Fundus photo — 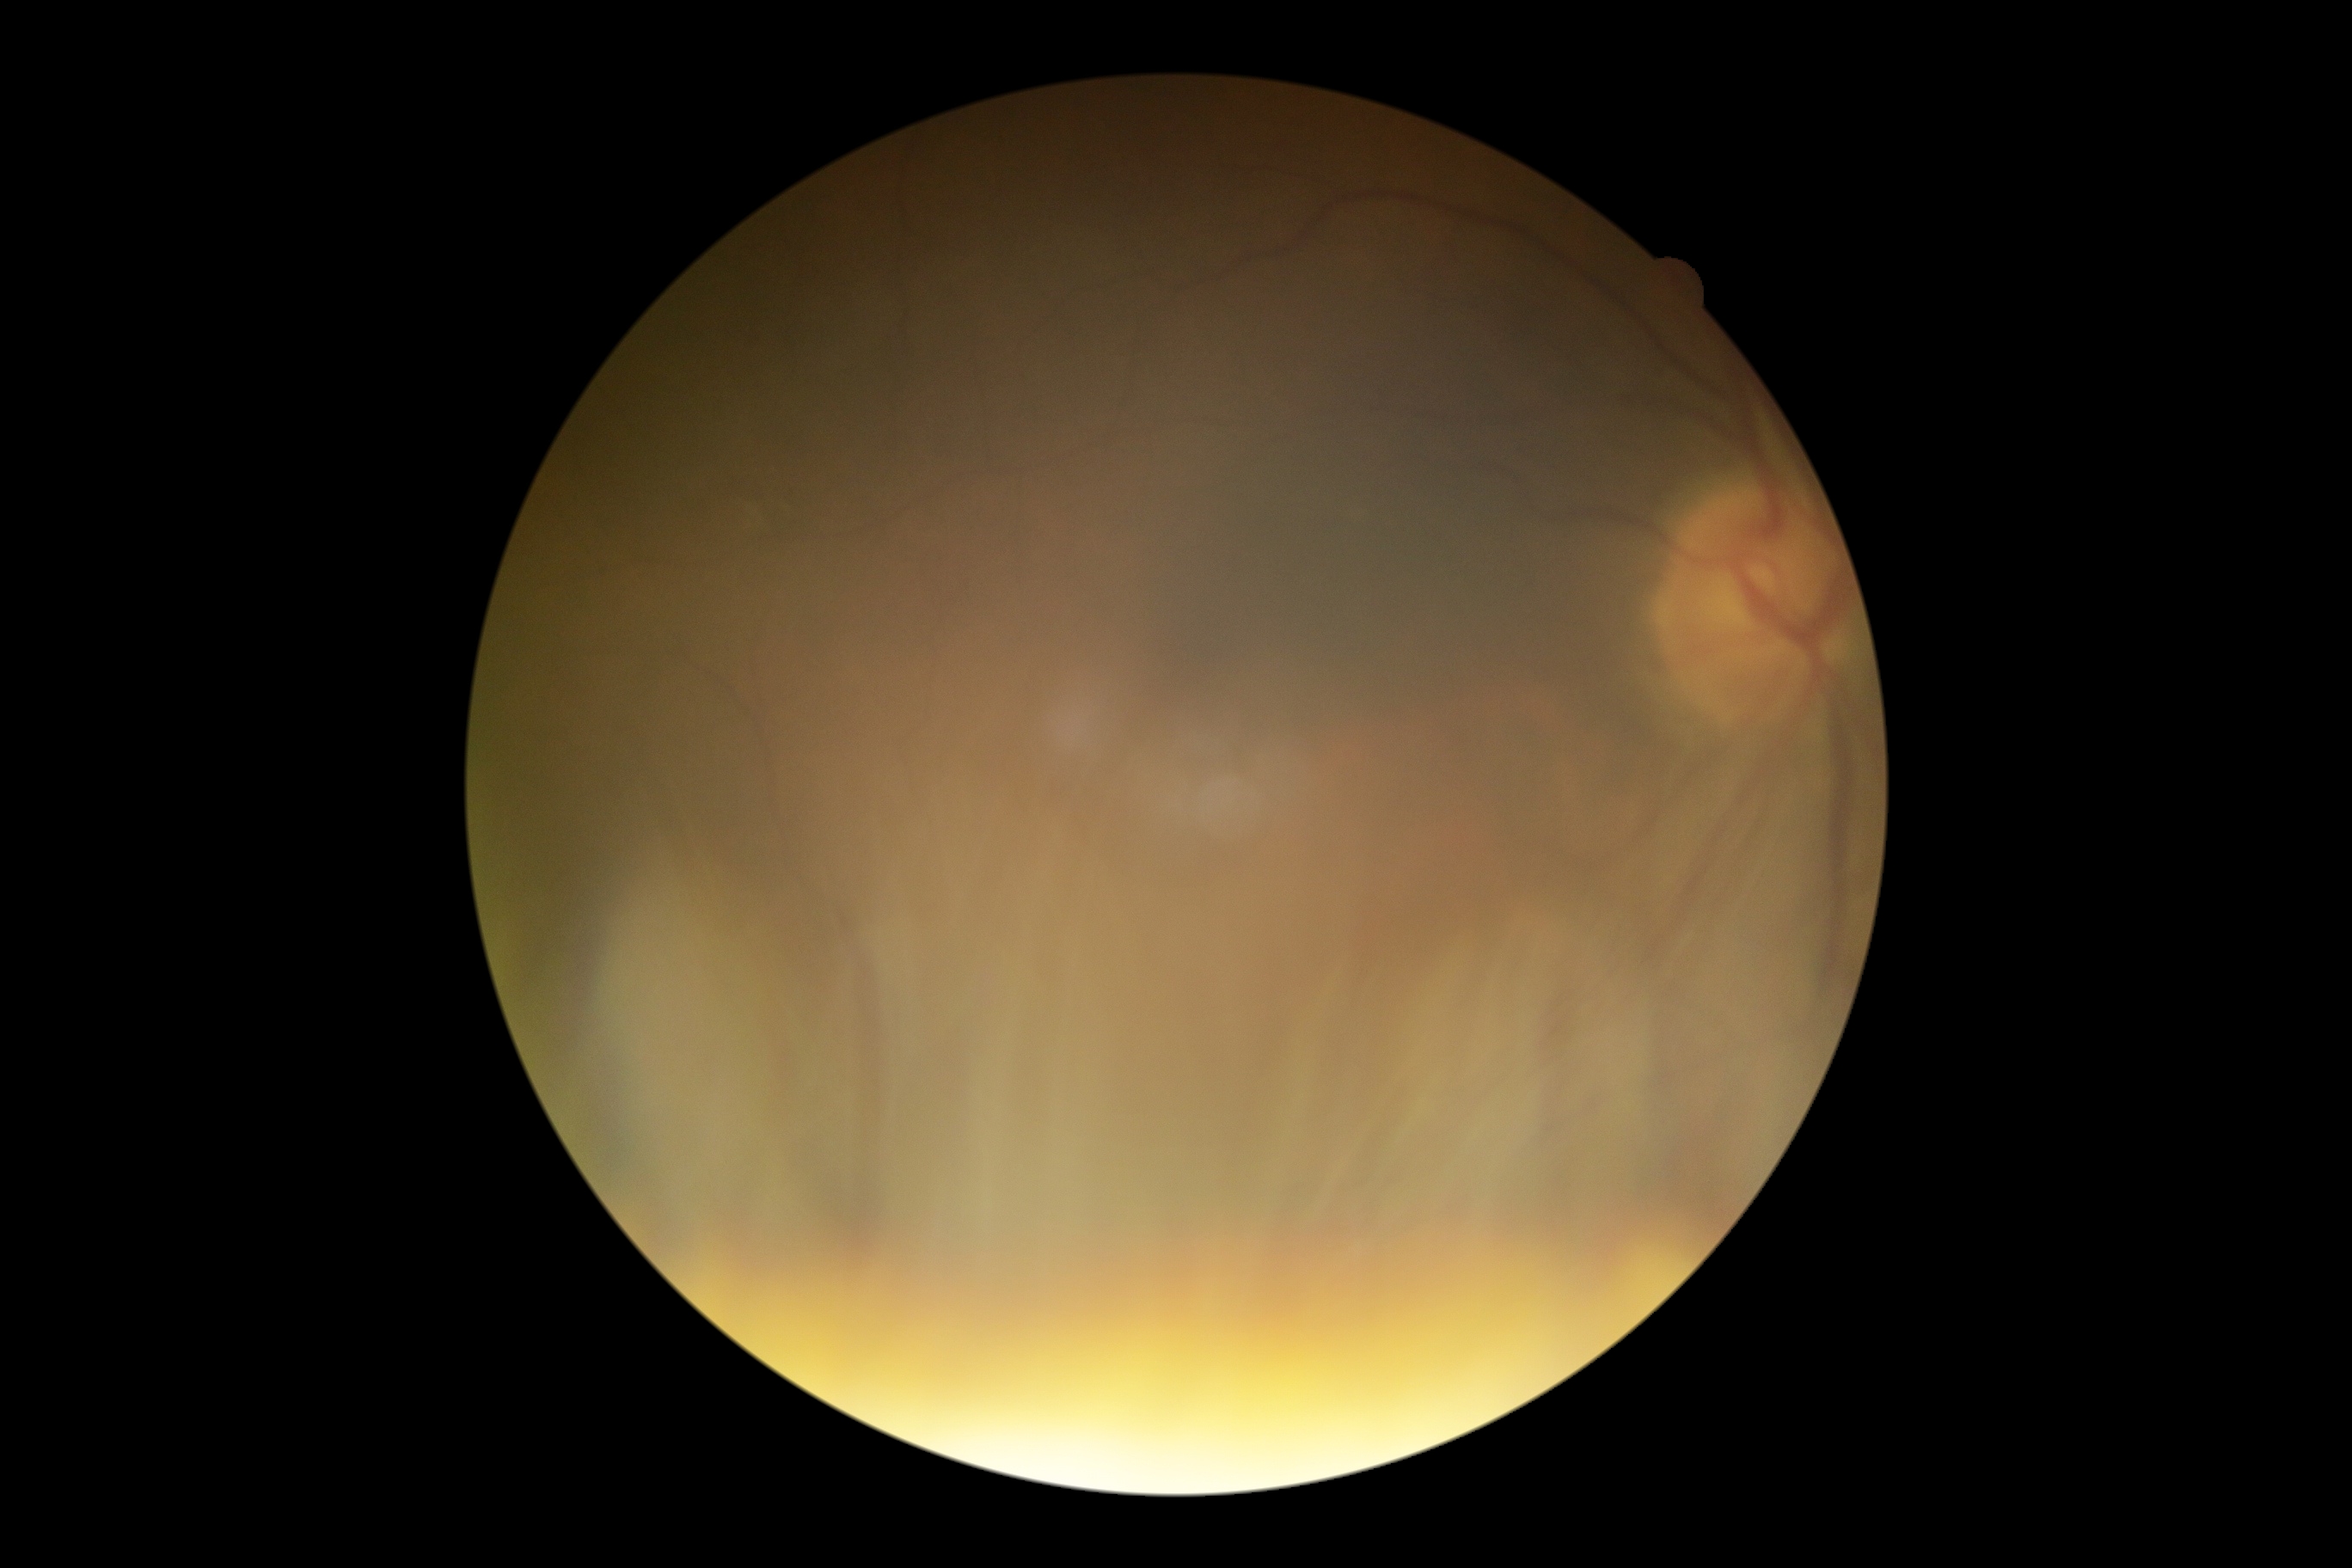
Quality too poor to assess for DR. DR stage: ungradable.